NIDEK AFC-230 fundus camera
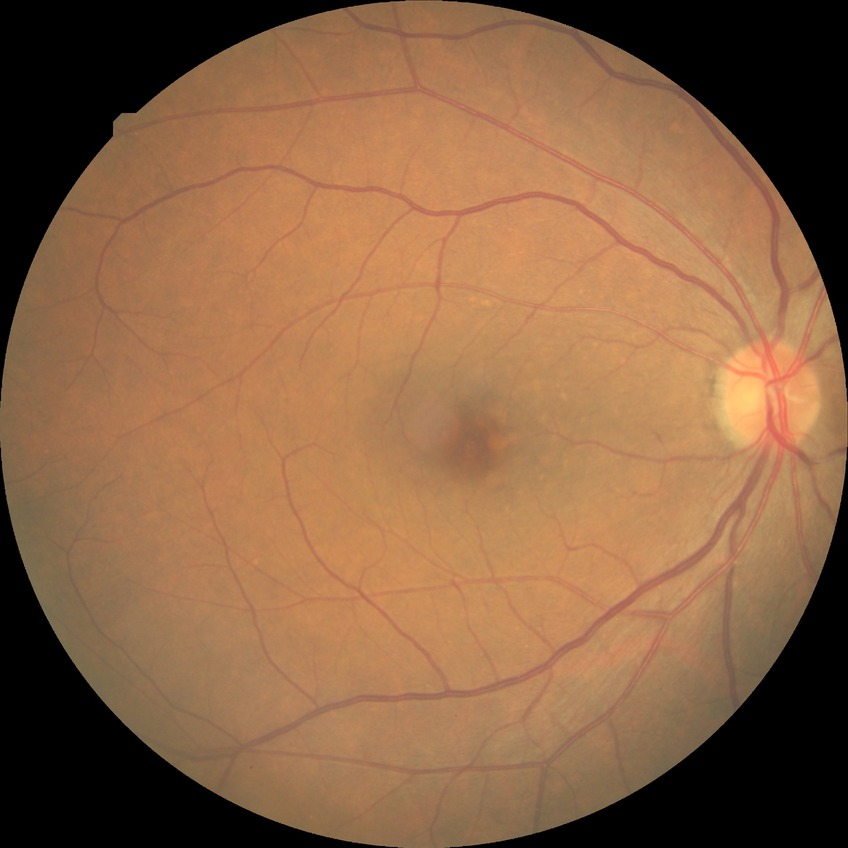 Diabetic retinopathy stage: no diabetic retinopathy.